Fundus photo
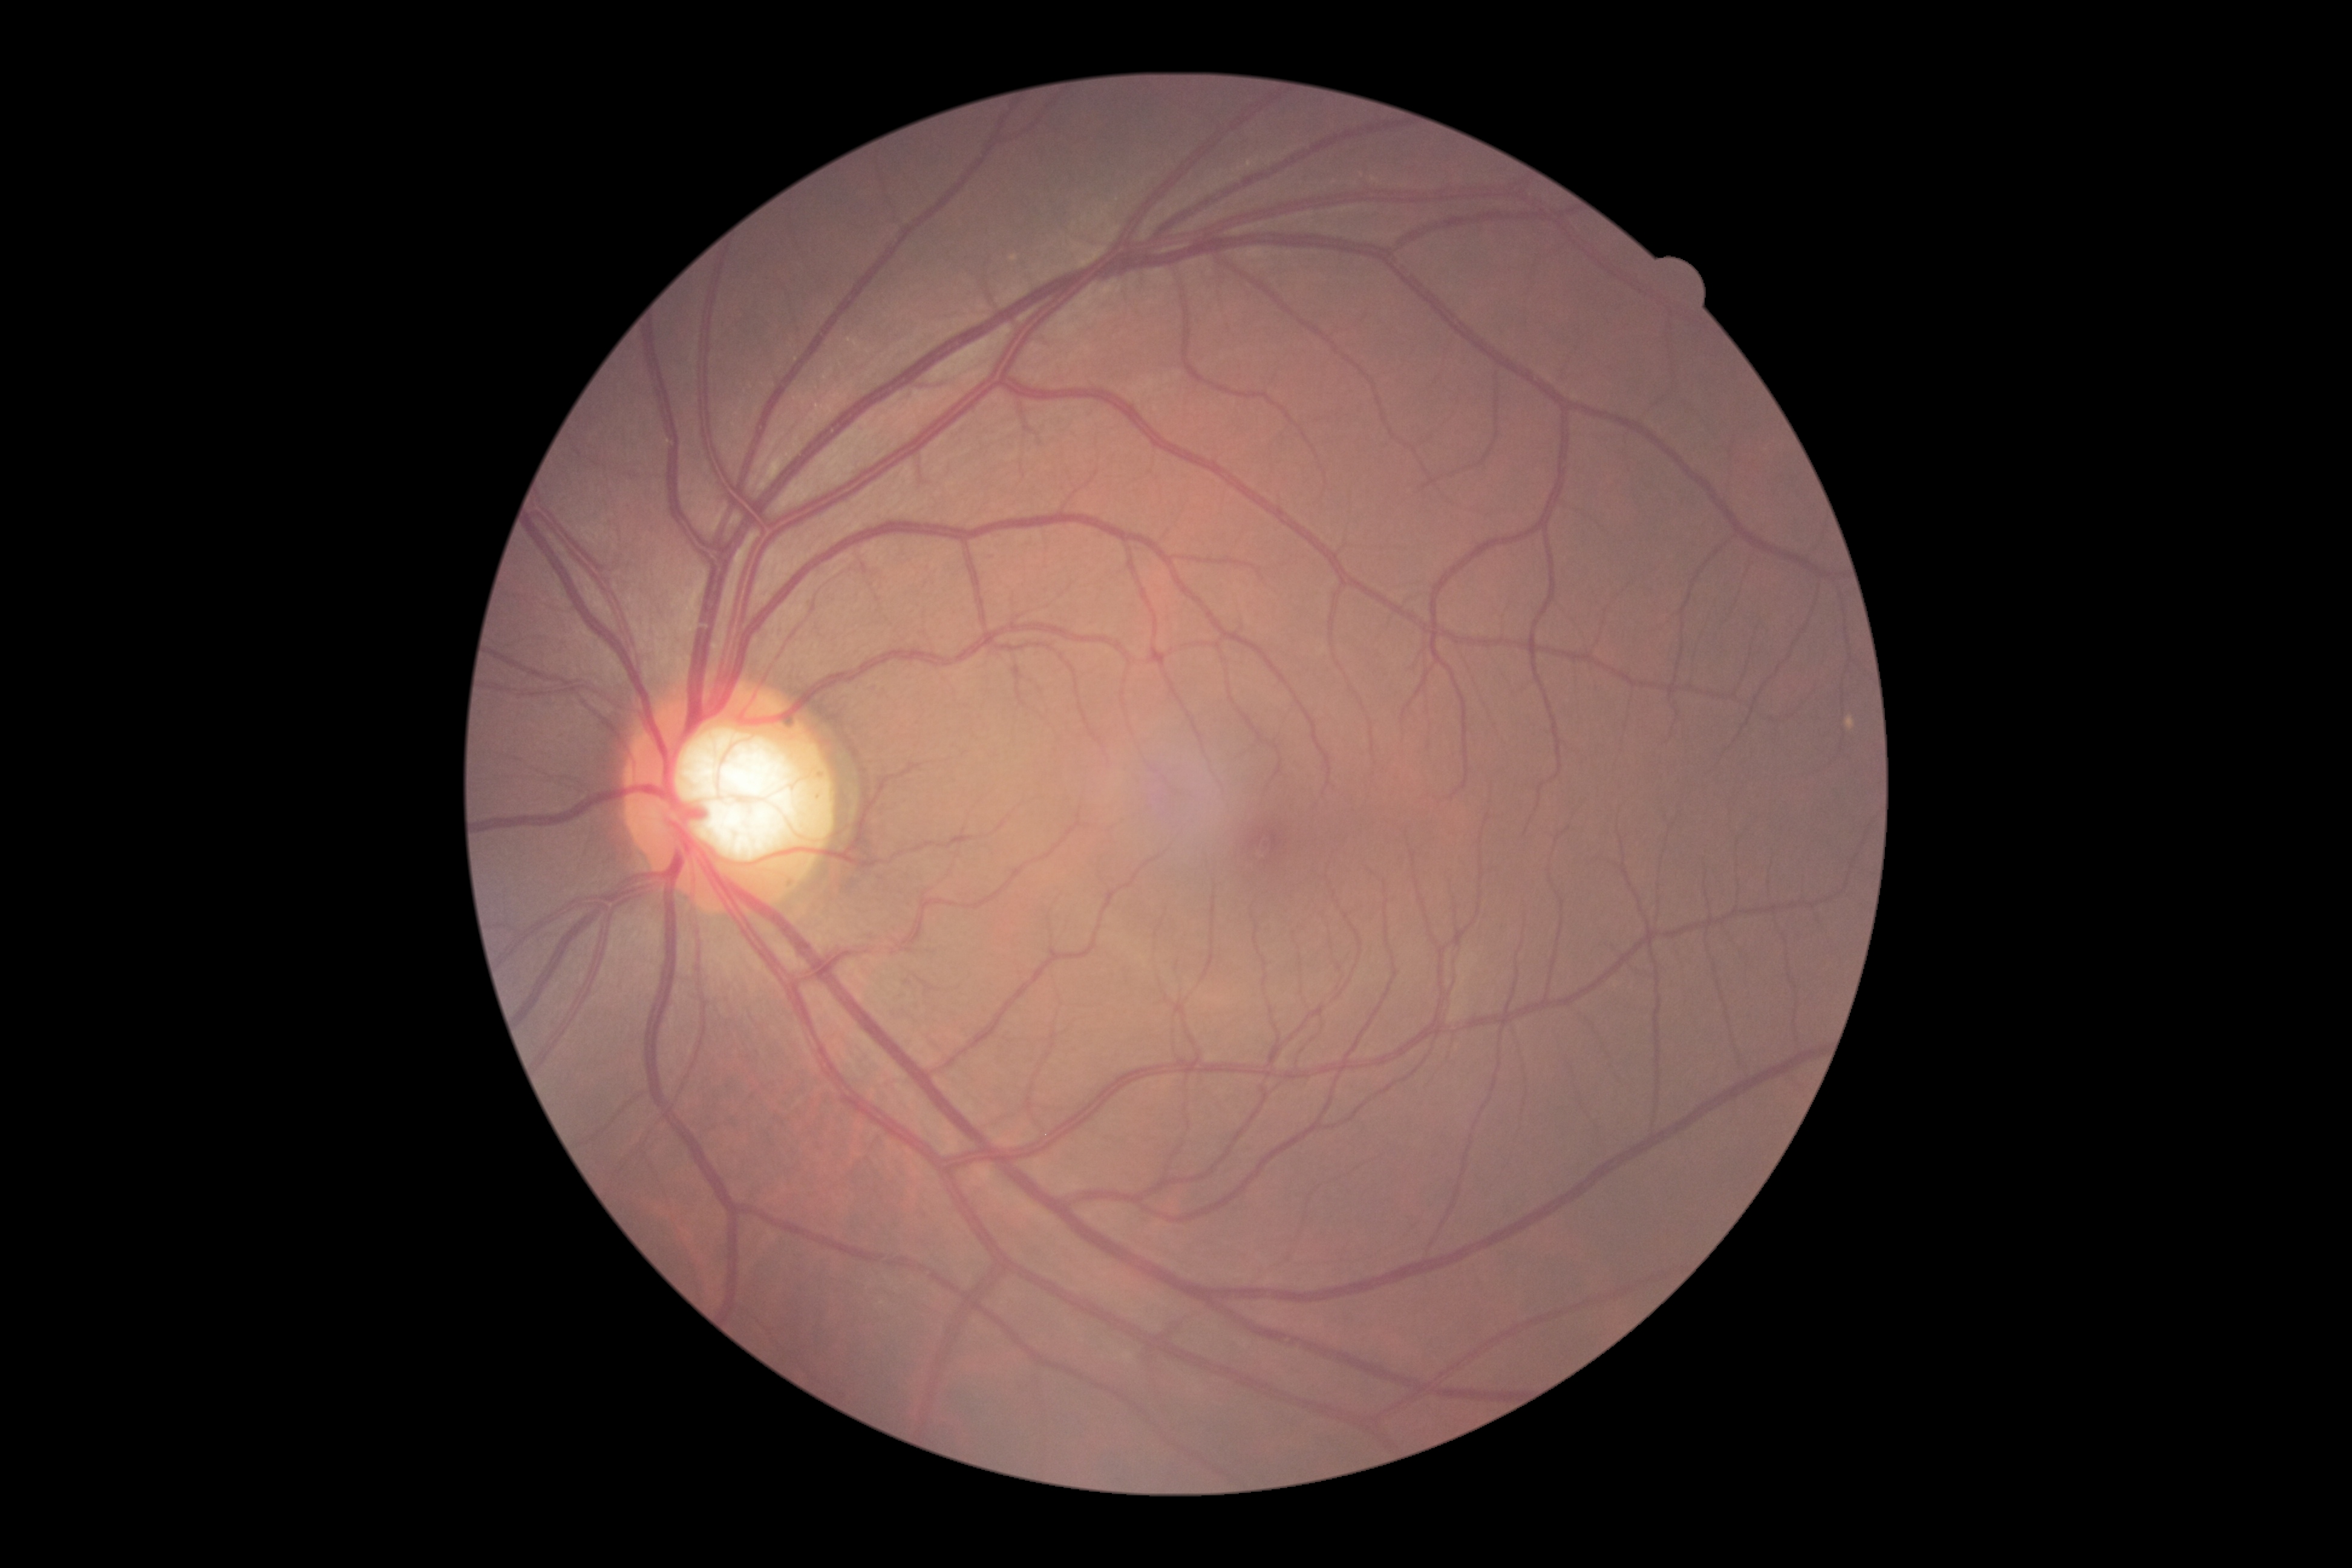 {
  "dr_grade": "0 (no apparent retinopathy)"
}